Fundus photo · image size 1659x2212 · acquired with a Remidio Fundus on Phone (FOP) camera
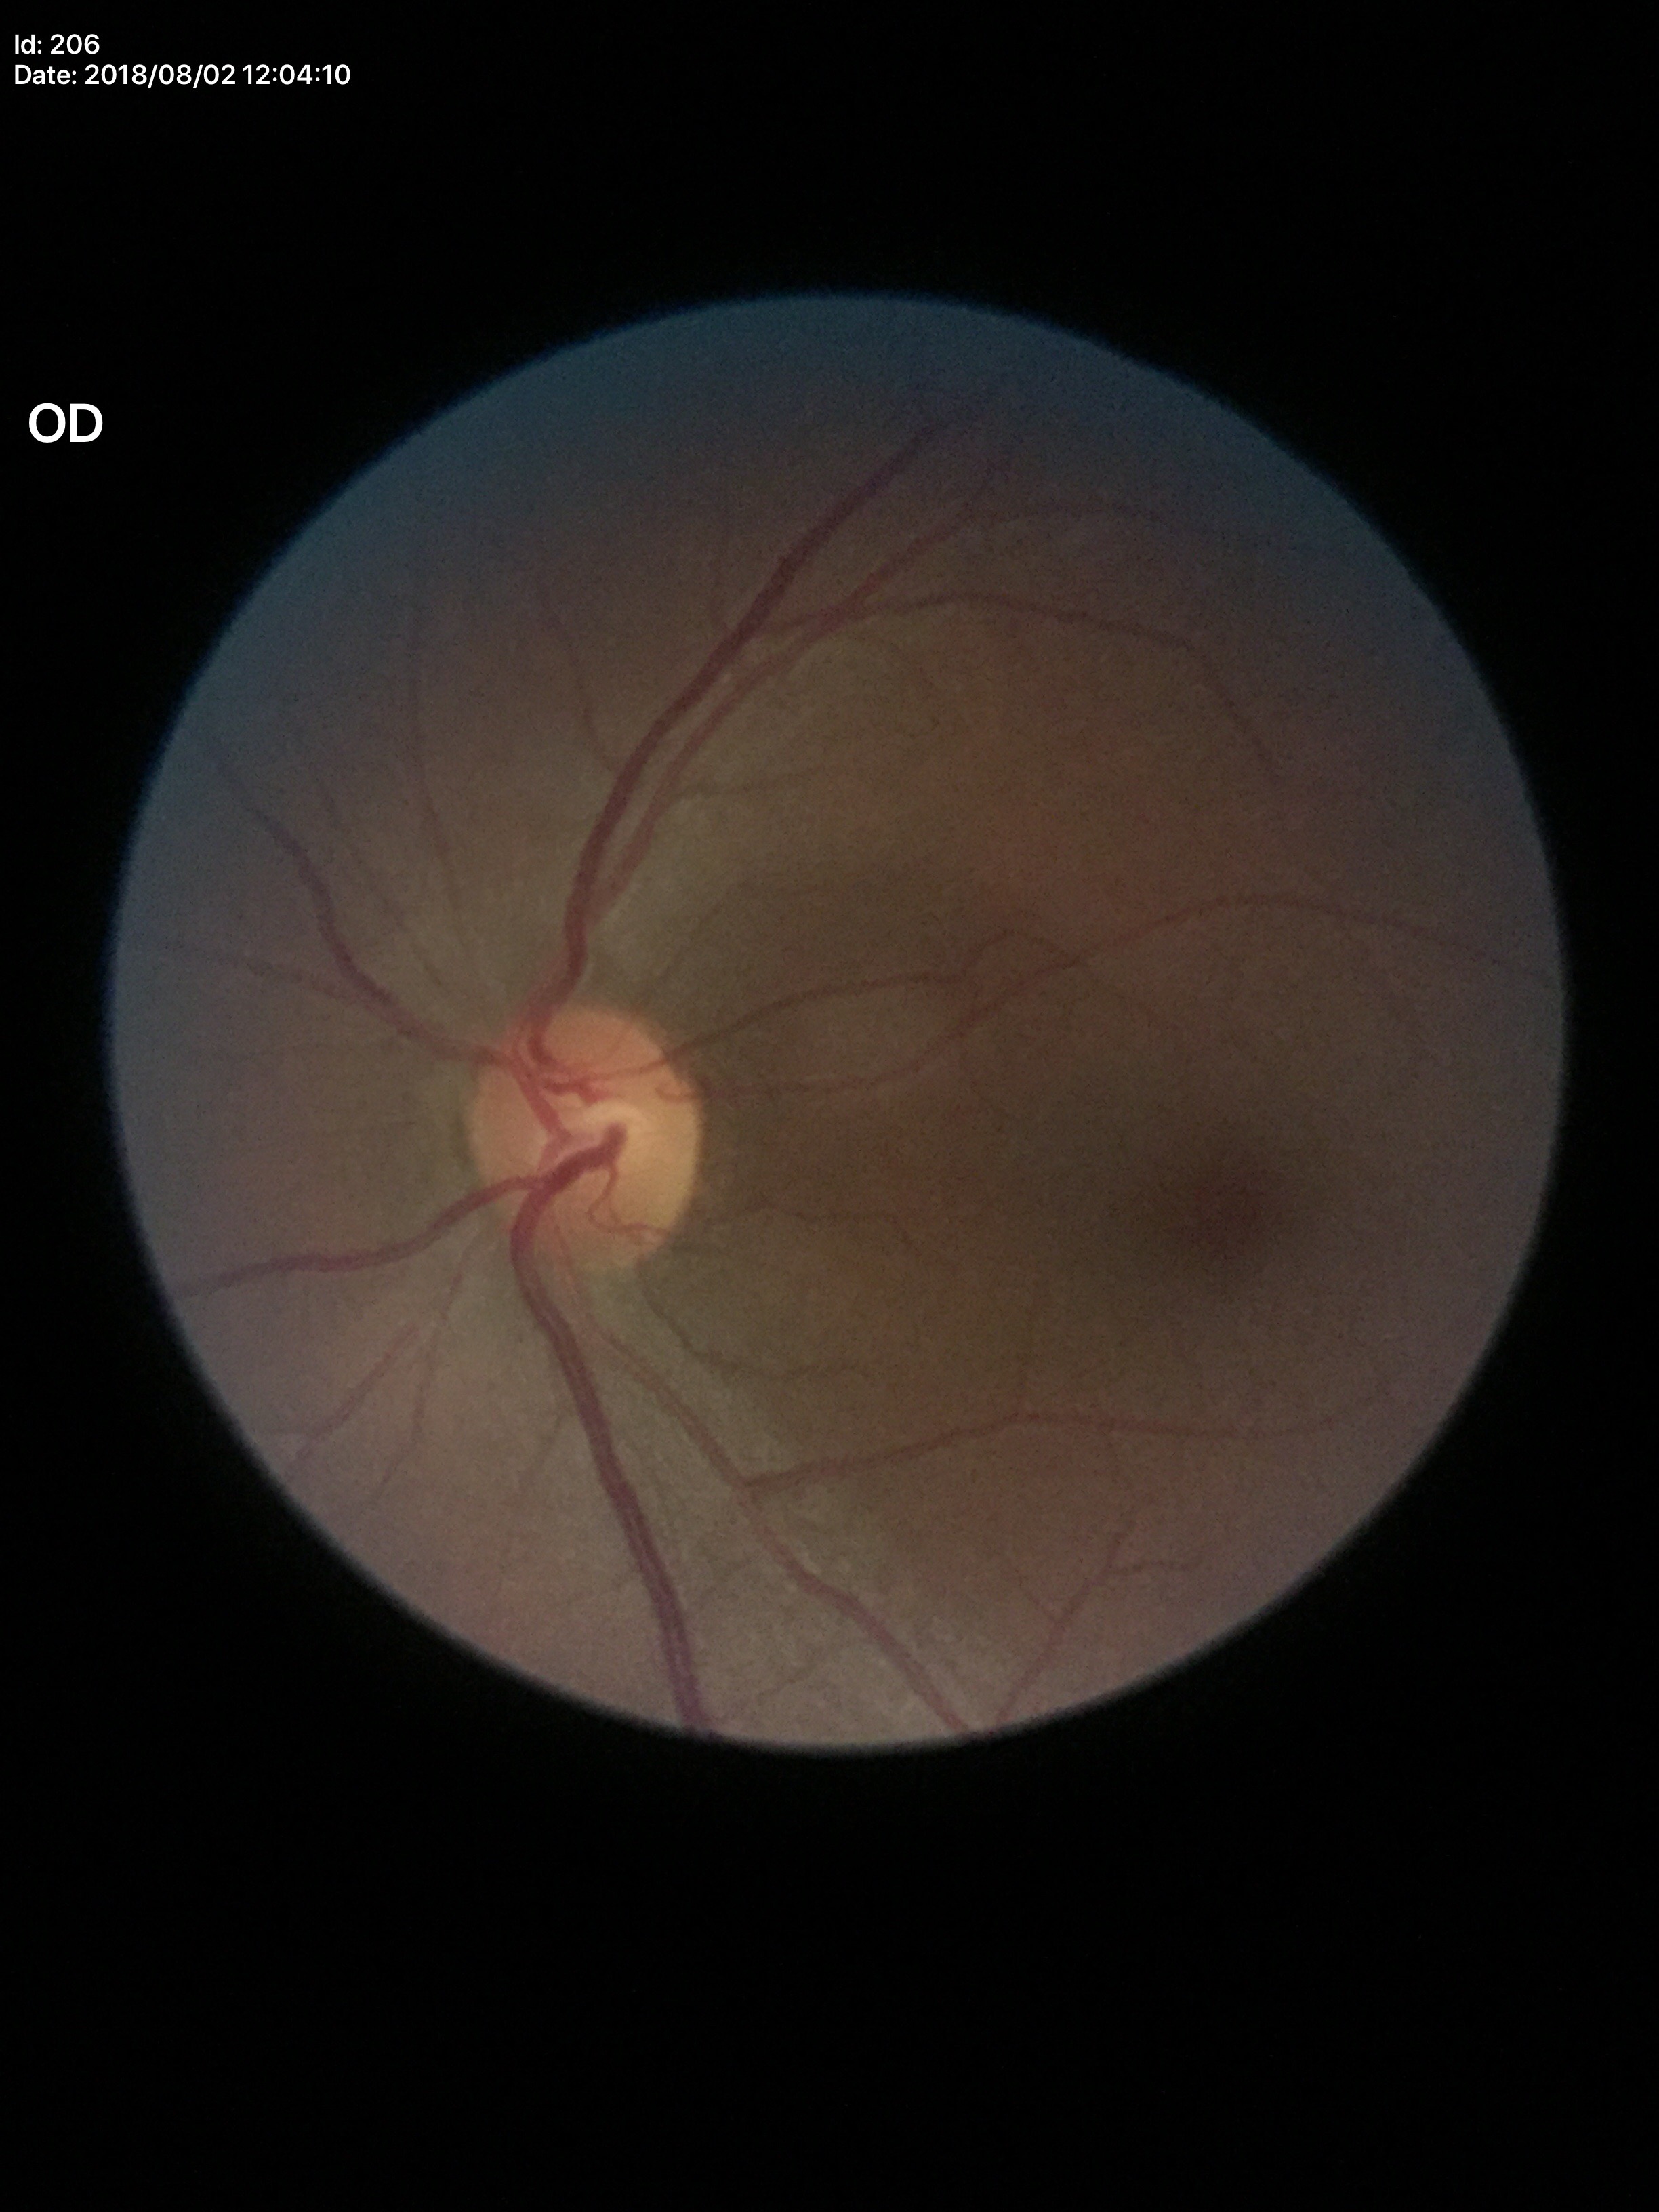
Annotations:
- Glaucoma screening impression — negative
- VCDR — 0.47